240x240; centered on the optic disc; non-mydriatic acquisition
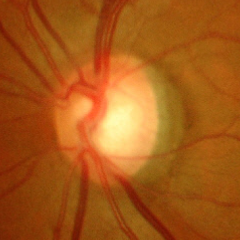

Optic nerve head appearance consistent with severe glaucomatous damage.